Wide-field contact fundus photograph of an infant. 1240x1240 — 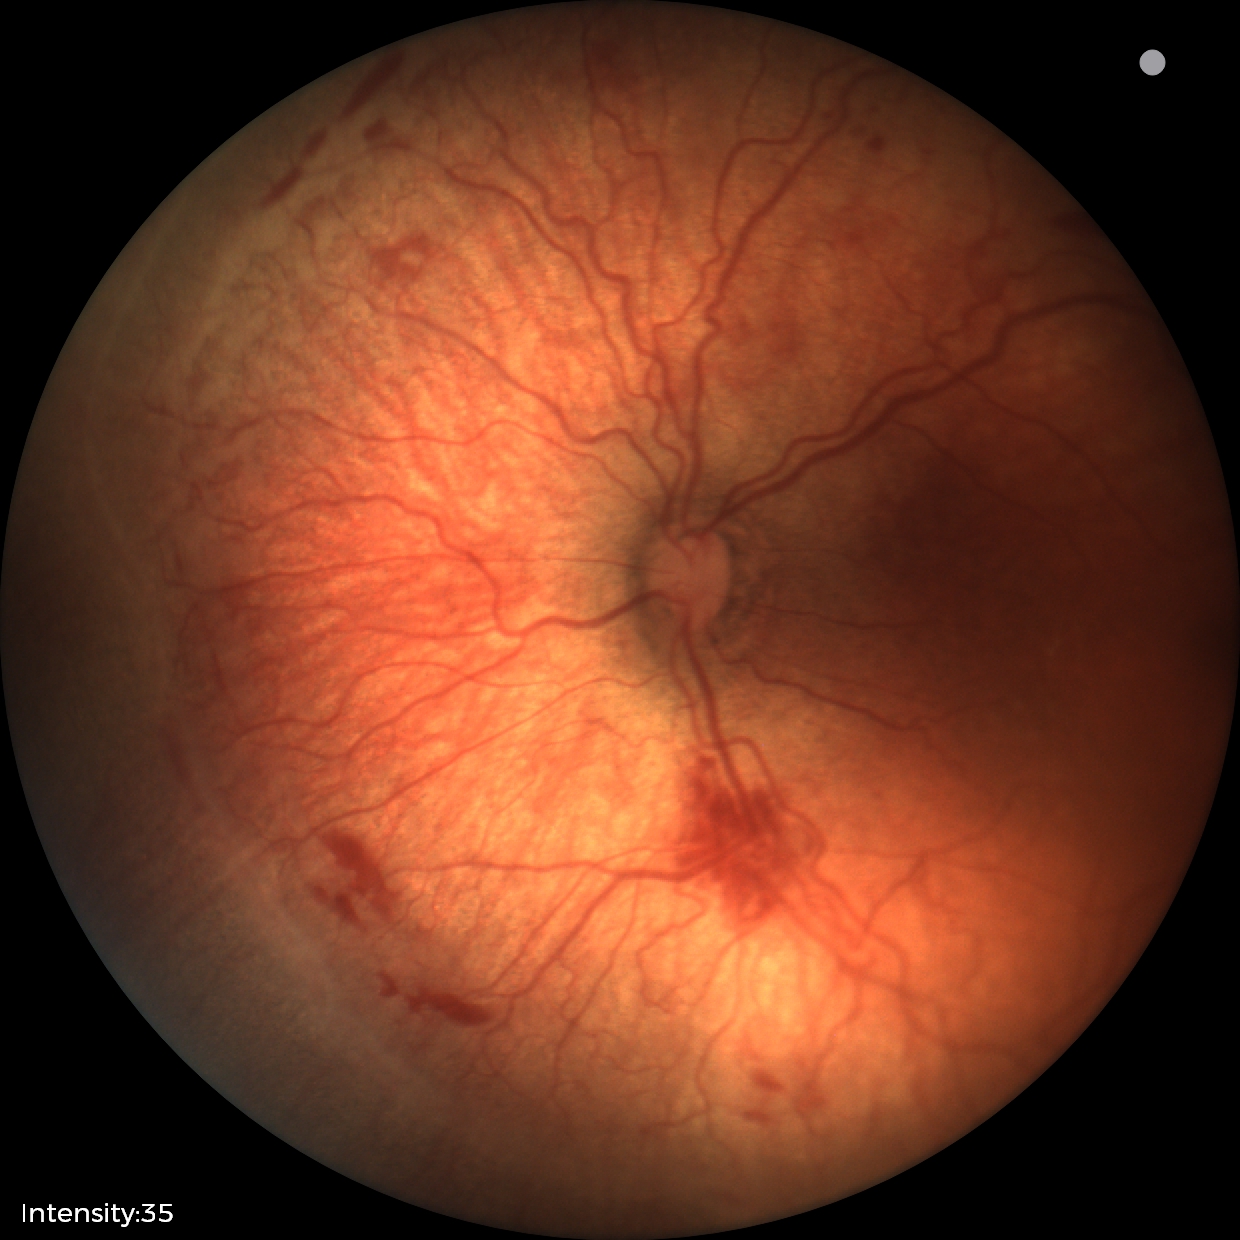 Assessment: retinopathy of prematurity (ROP) stage 2.